Wide-field fundus photograph of an infant · image size 640x480: 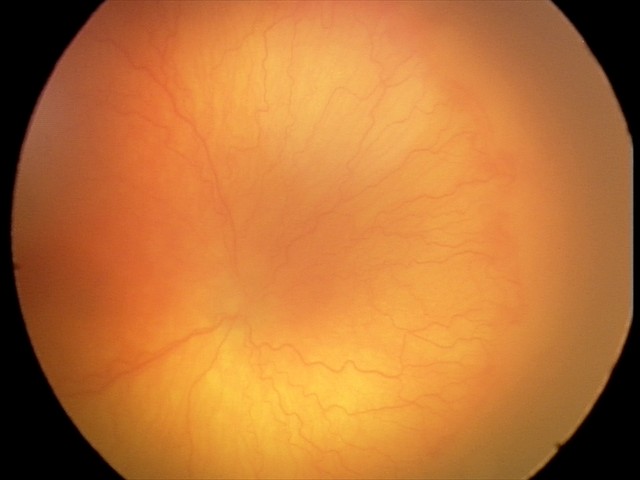

From an examination with diagnosis of A-ROP (aggressive ROP).